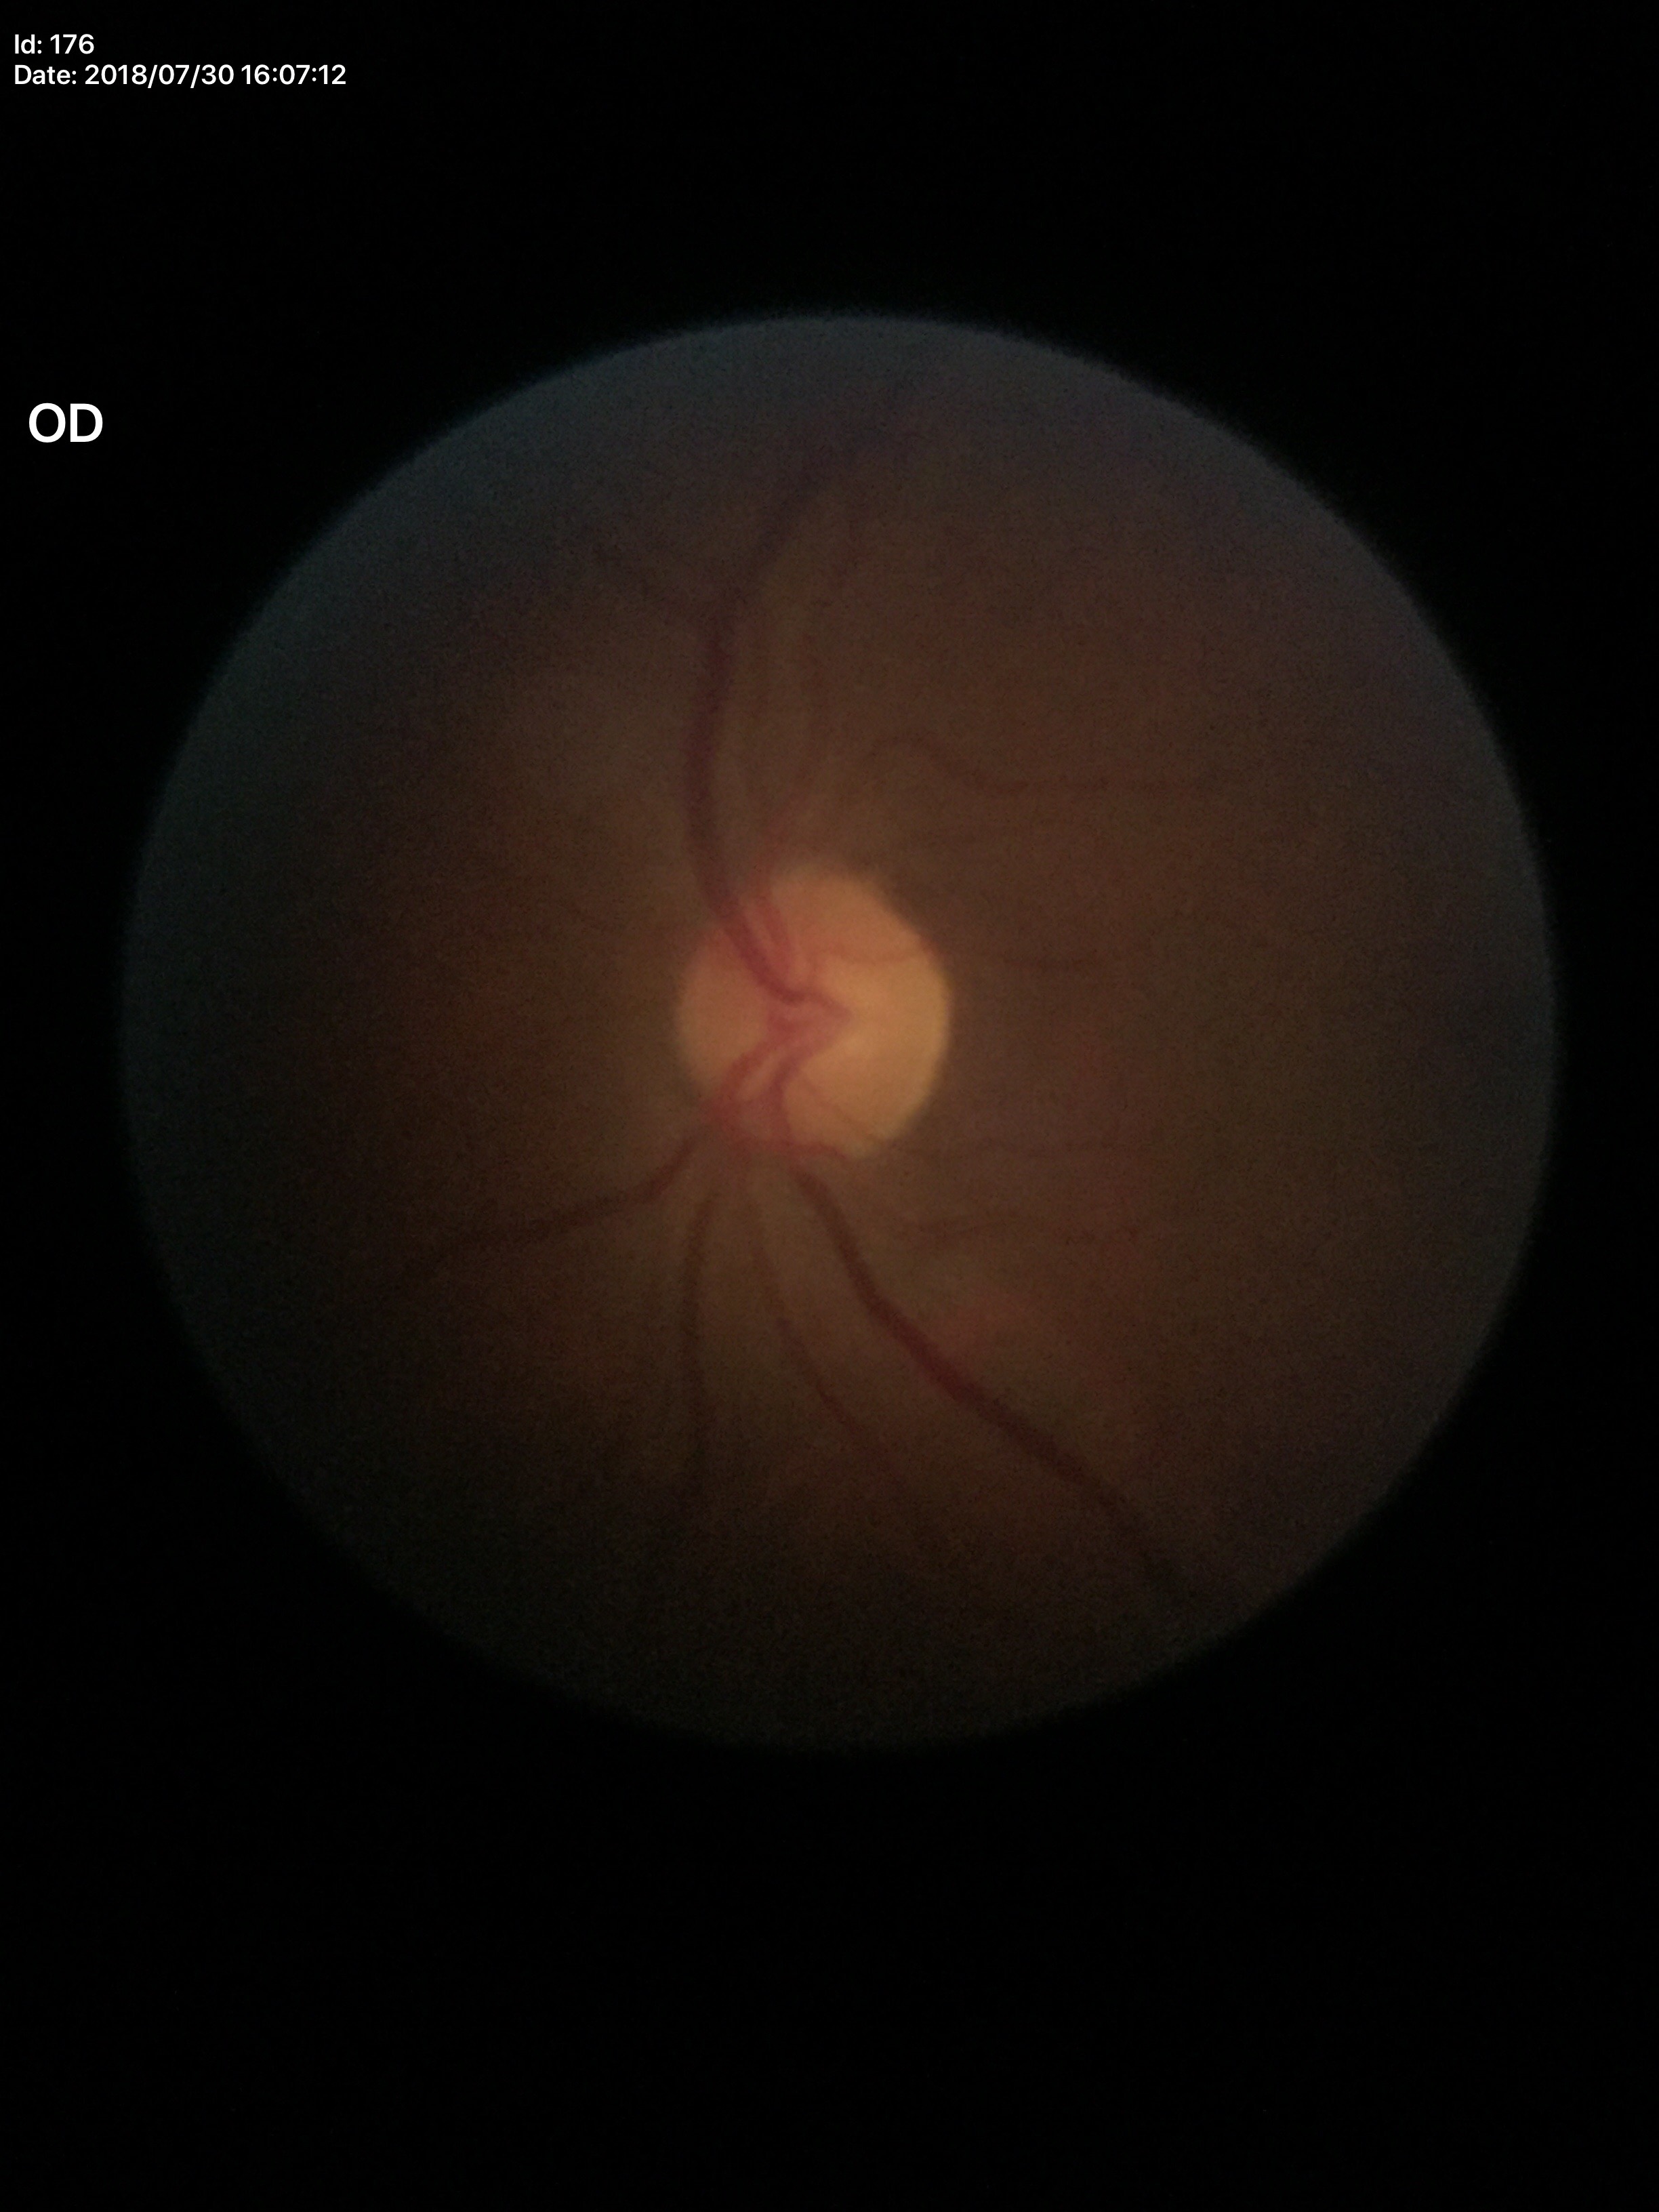 Q: What is the vertical cup-to-disc ratio?
A: 0.46
Q: Is there glaucoma suspicion?
A: no suspicious findings
Q: What is the horizontal cup-to-disc ratio?
A: 0.53